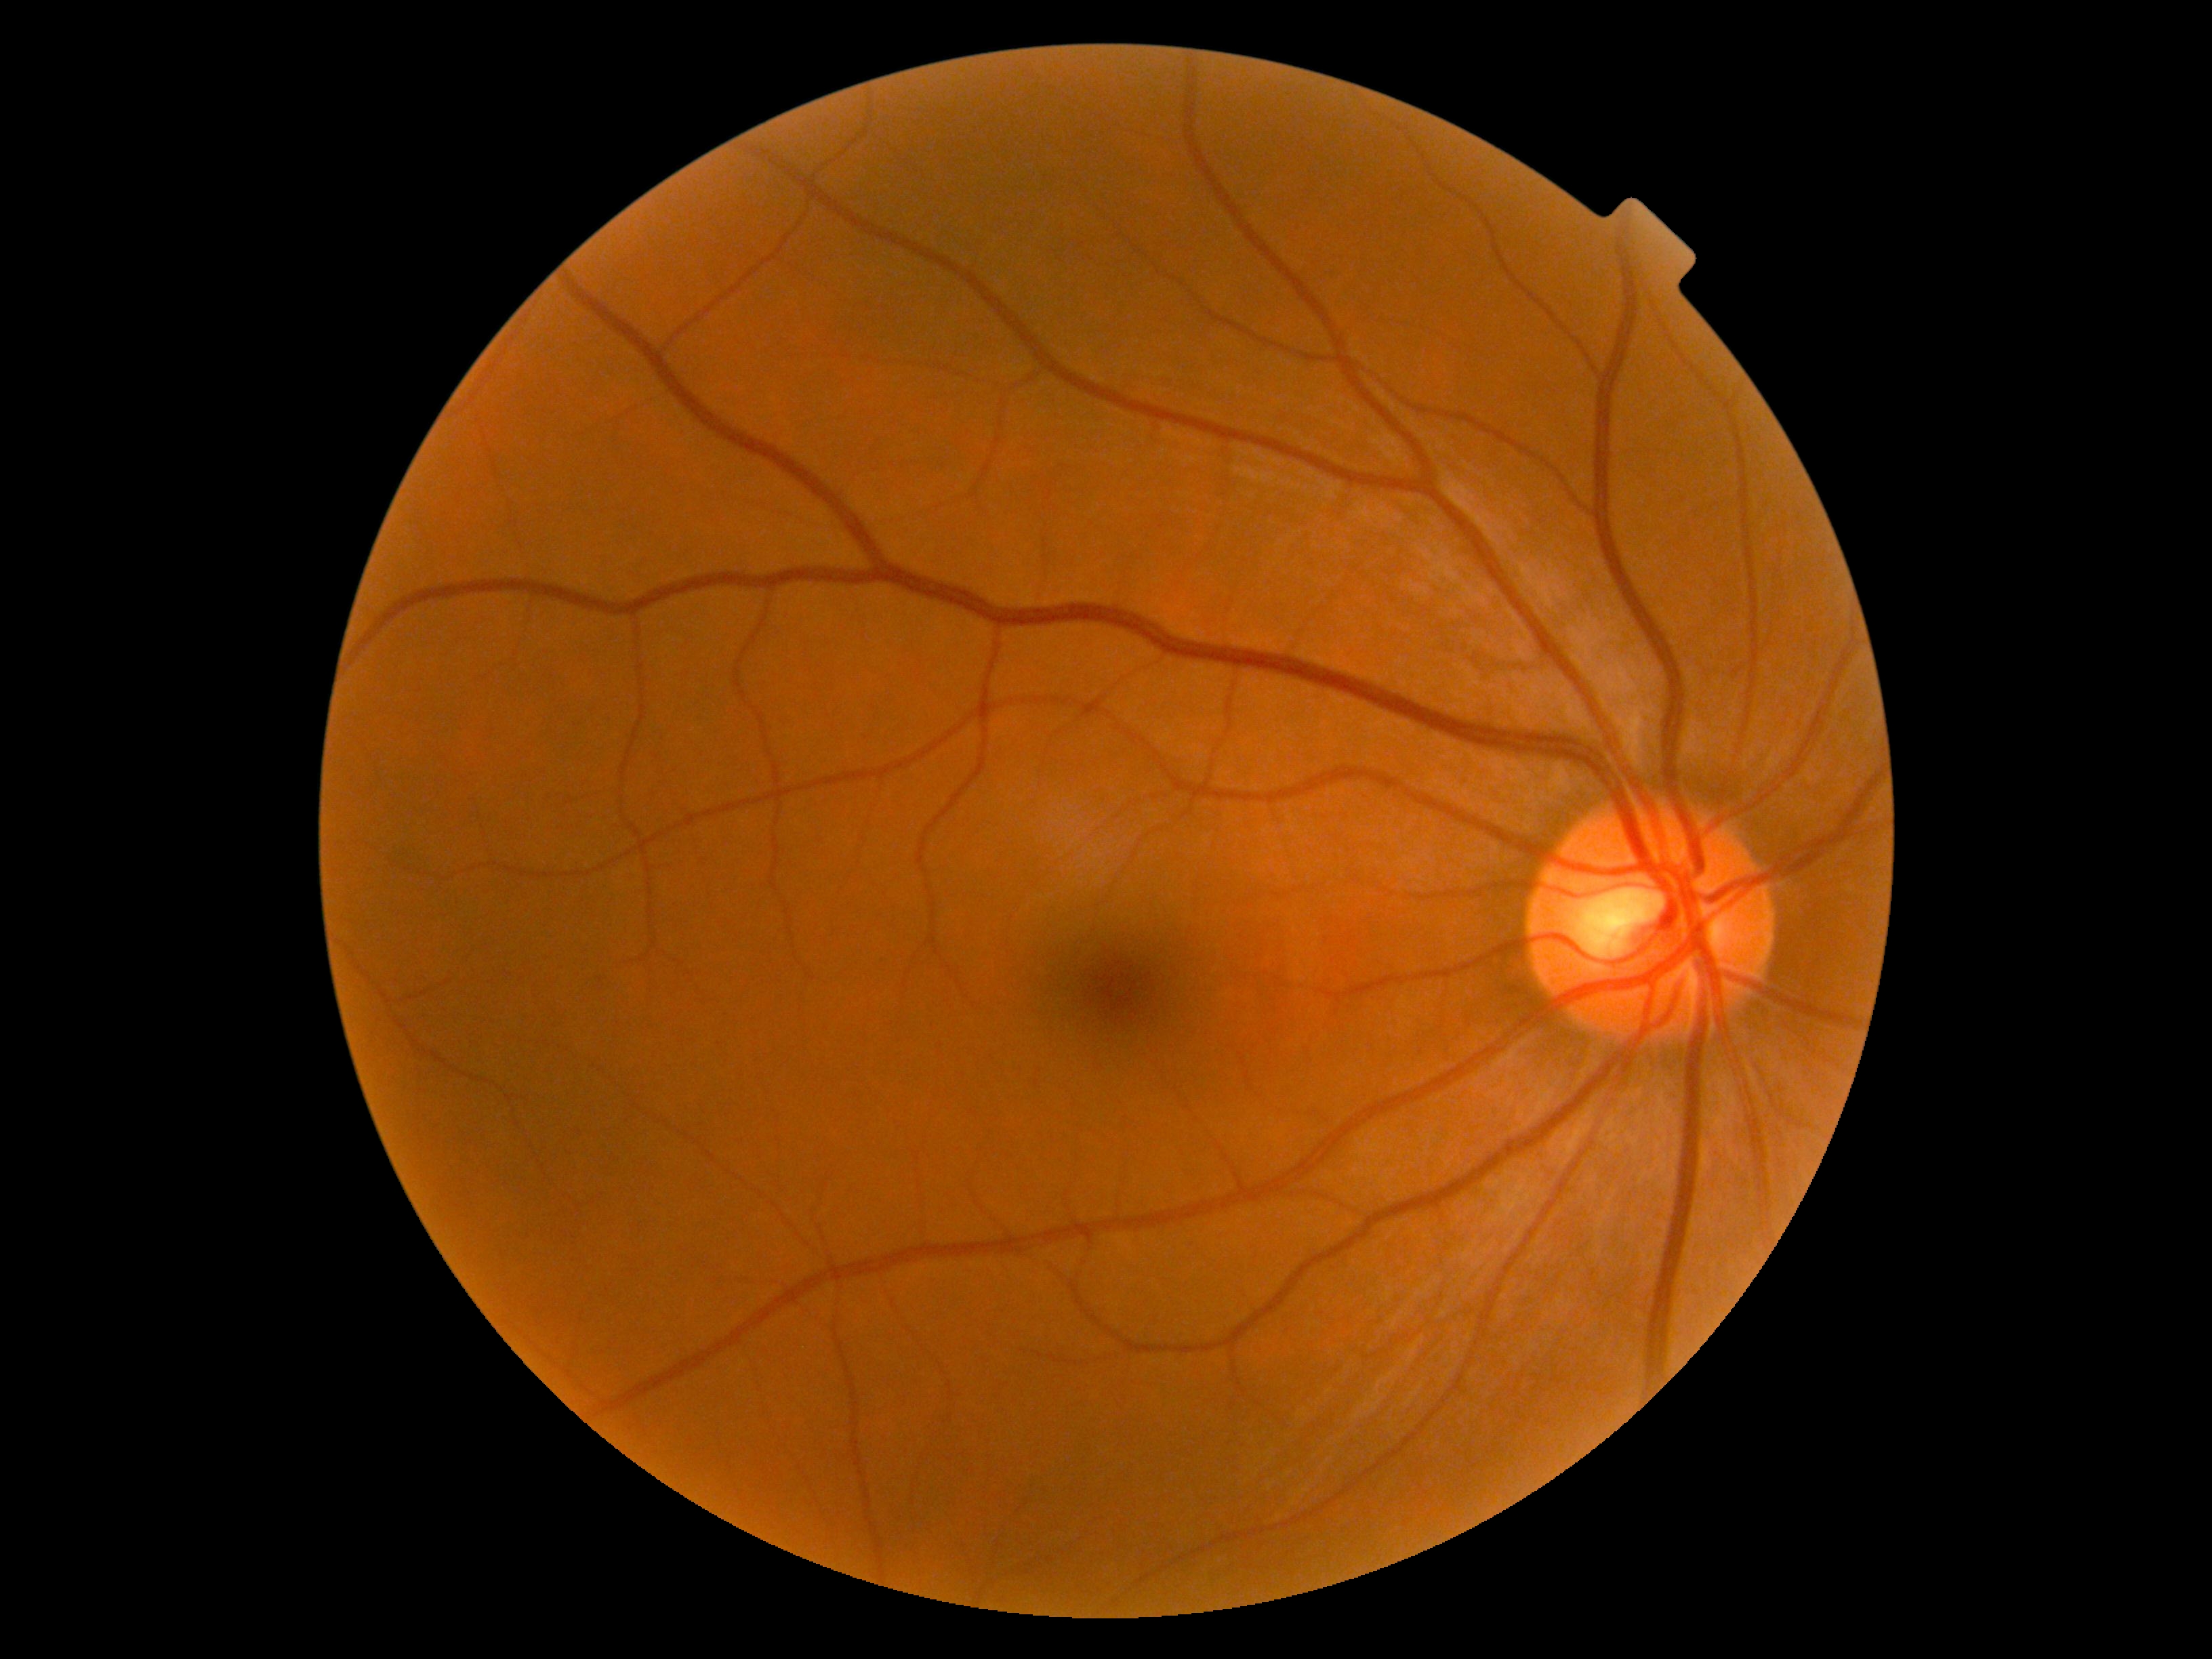
DR impression@no DR findings, DR severity@no apparent diabetic retinopathy (grade 0).